Wide-field fundus photograph from neonatal ROP screening; 640x480px; 130° field of view (Clarity RetCam 3) — 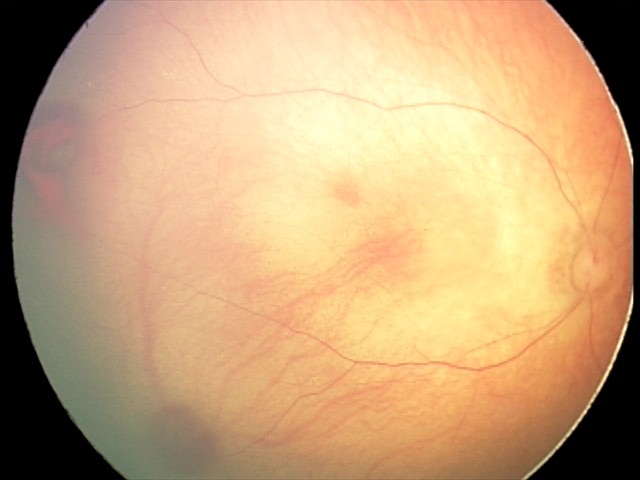

Series diagnosed as retinal hemorrhages.